Camera: Phoenix ICON (100° FOV); wide-field contact fundus photograph of an infant
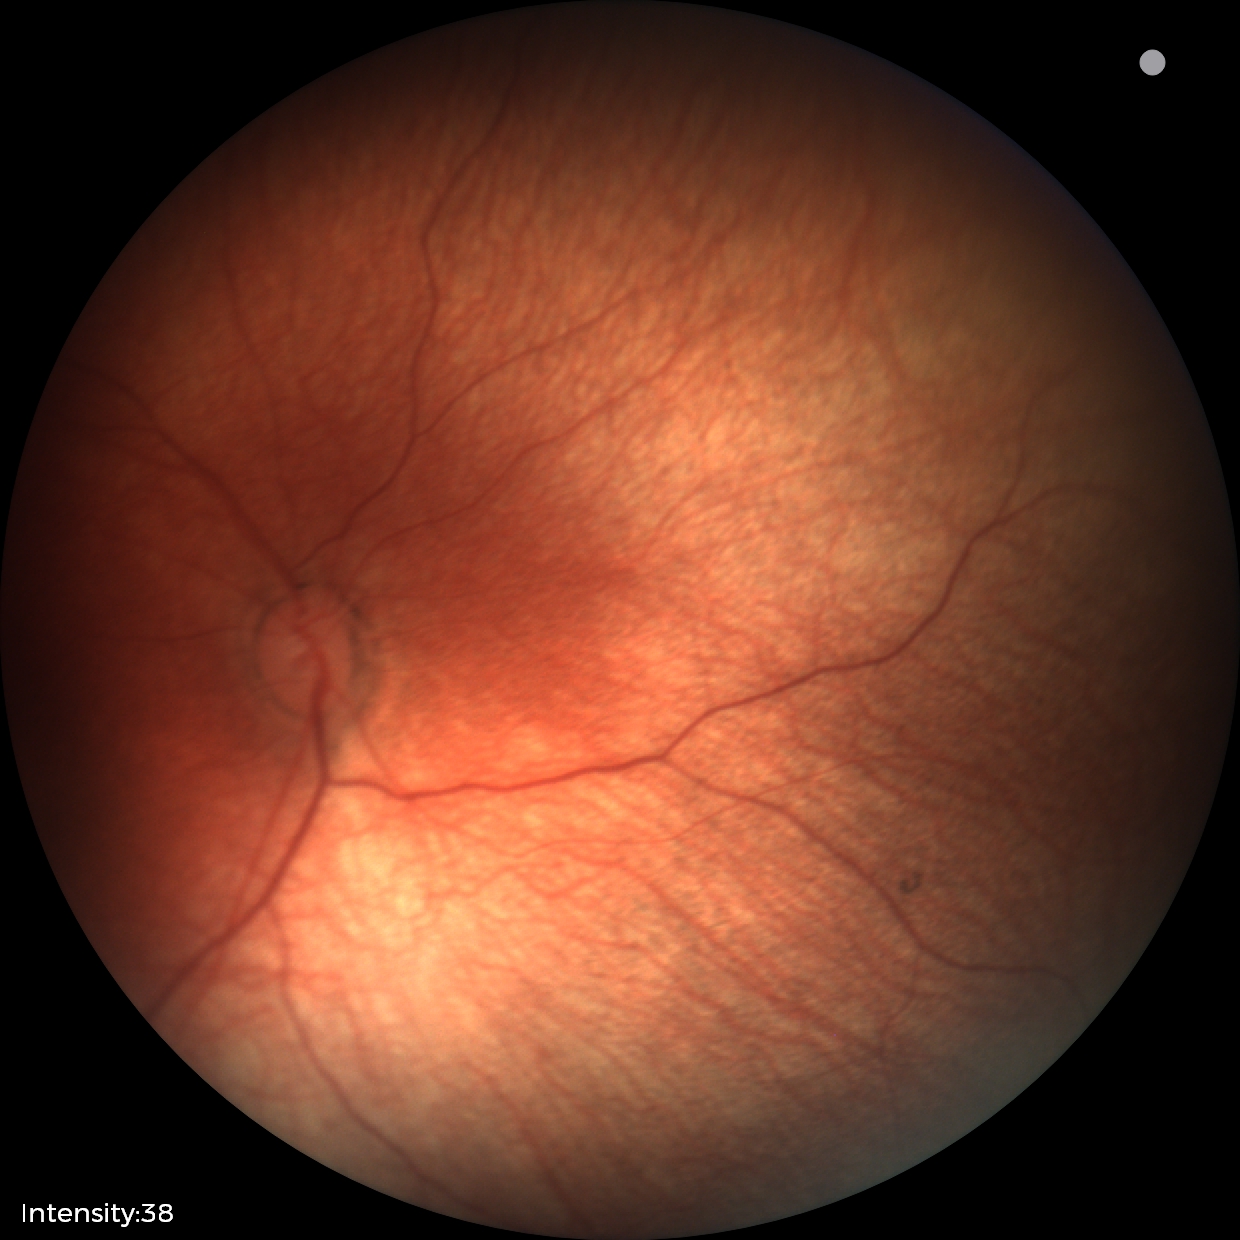
Examination with physiological retinal findings.